1659 x 2212 pixels; retinal fundus photograph; captured on a Remidio FOP fundus camera:
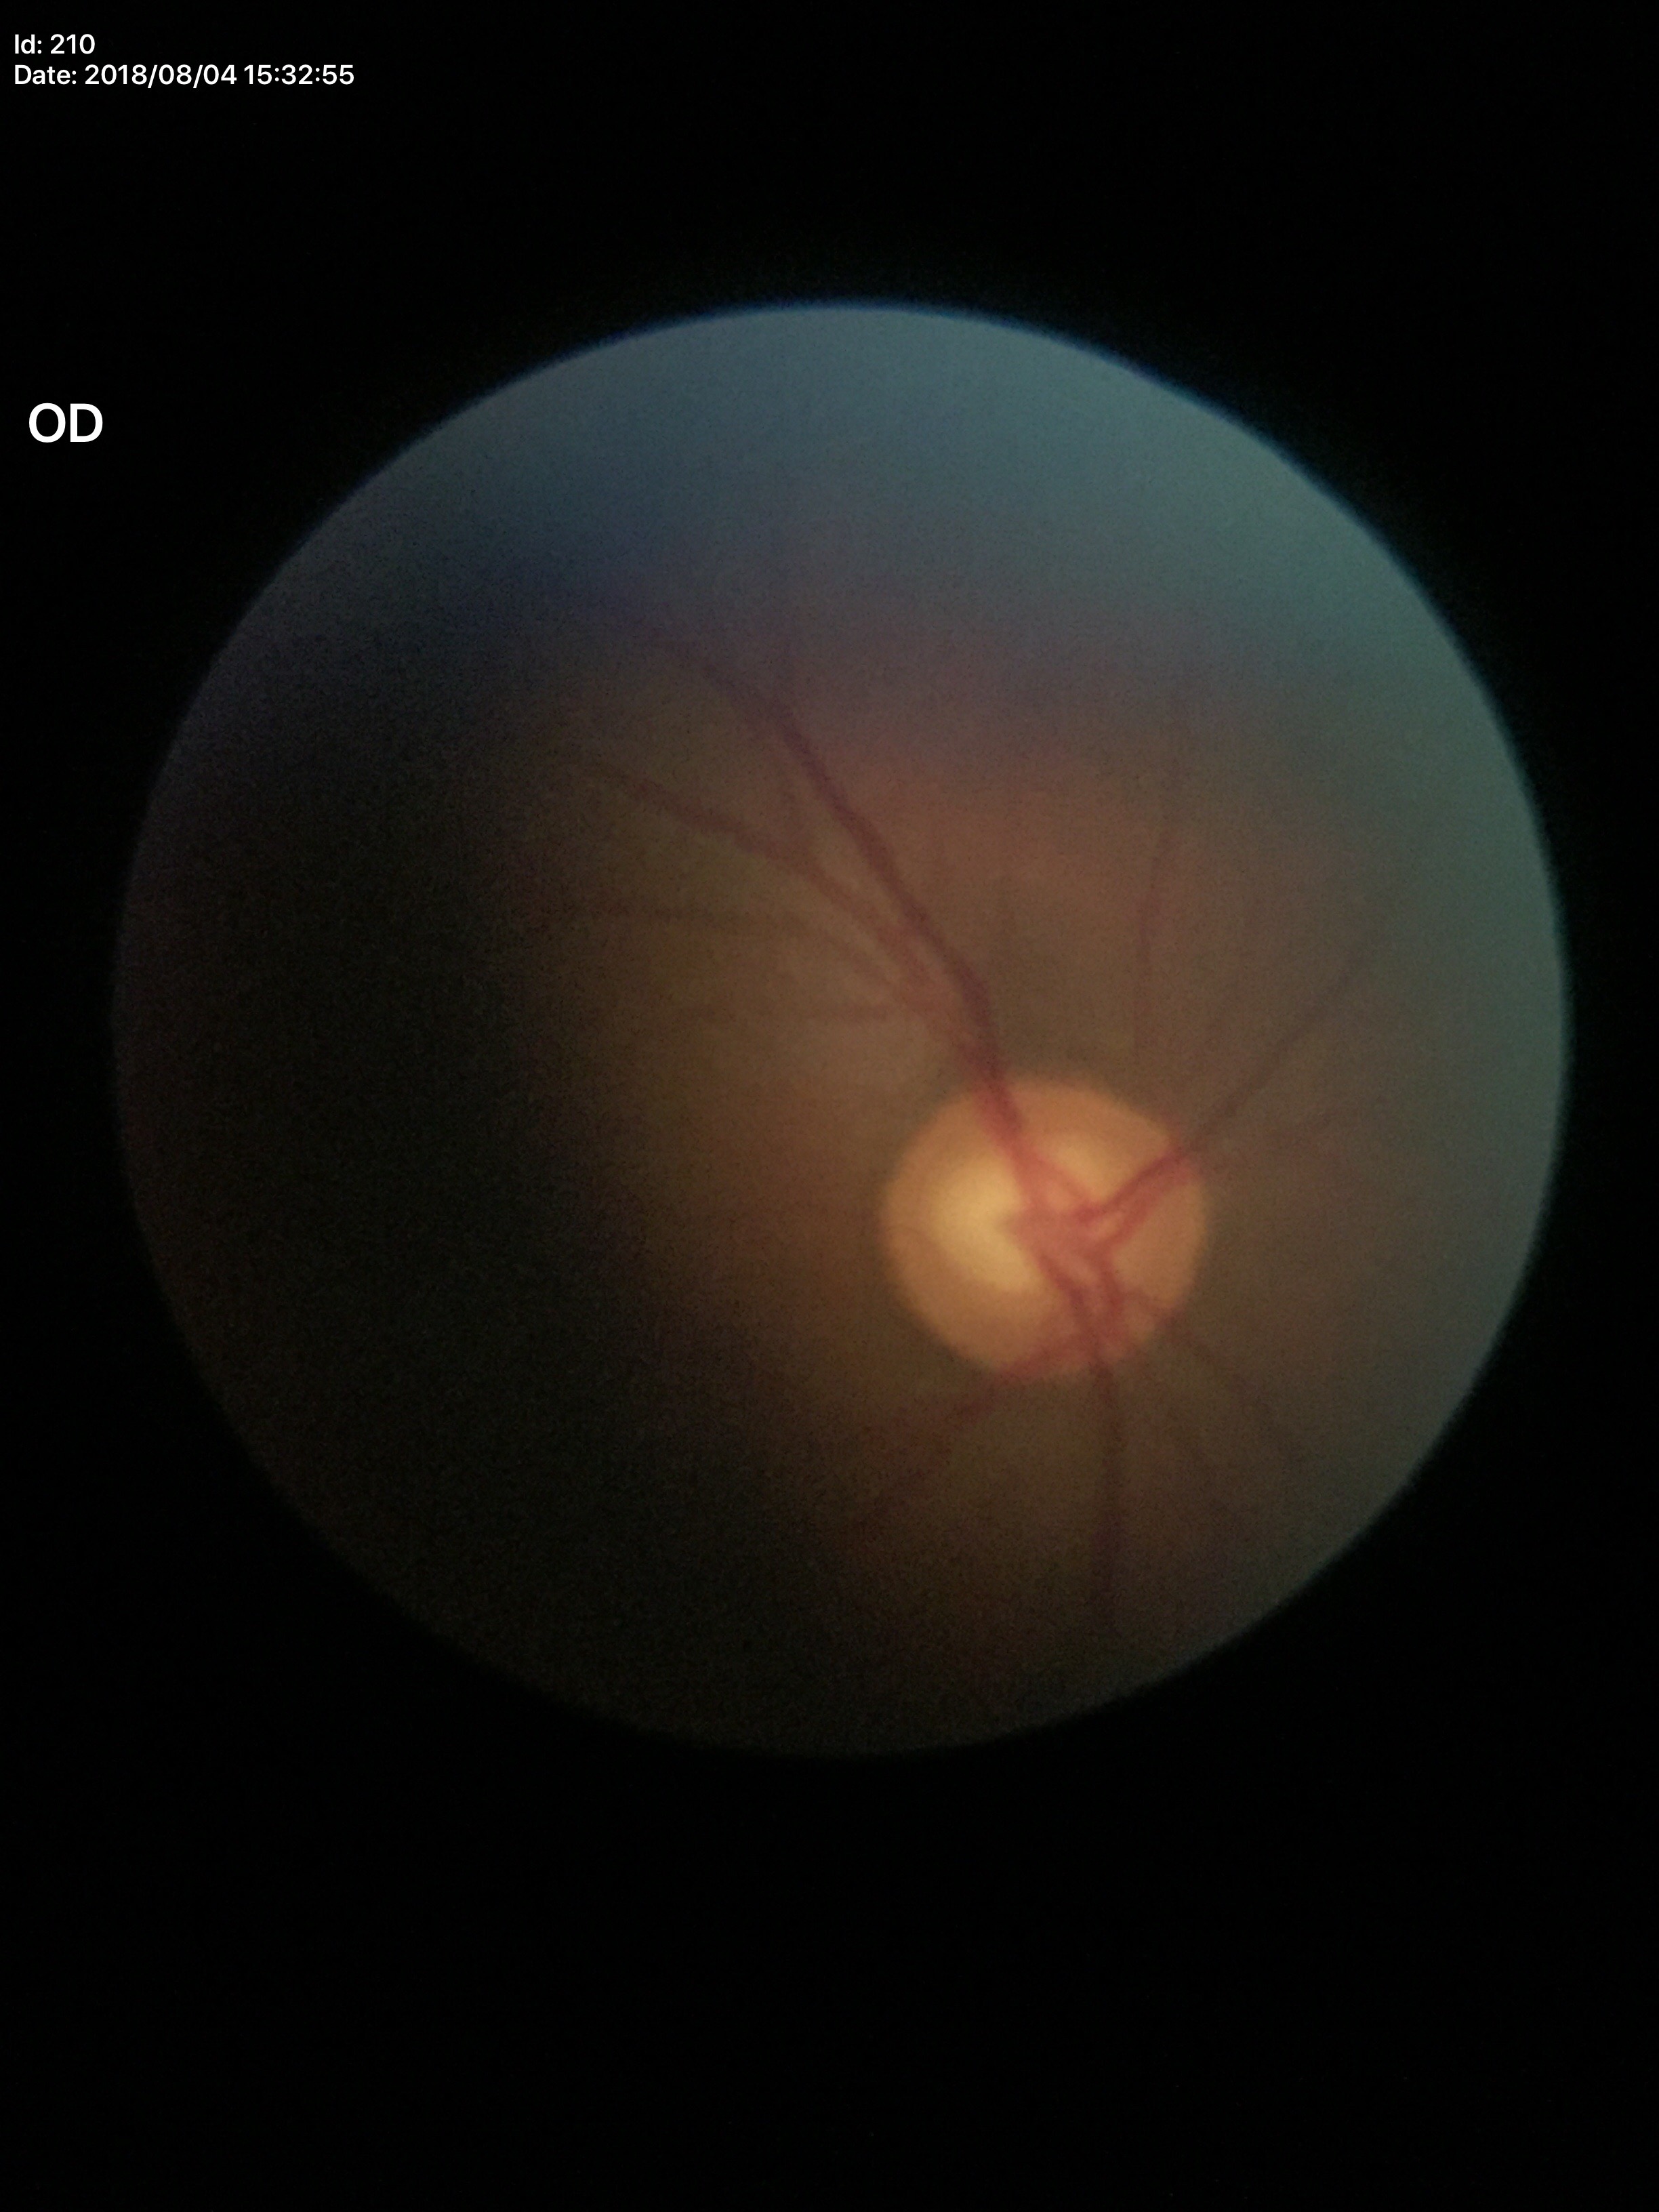

Q: Glaucoma screening result?
A: no suspicious findings
Q: What is the vertical cup-to-disc ratio?
A: 0.60
Q: Horizontal CDR?
A: 0.69